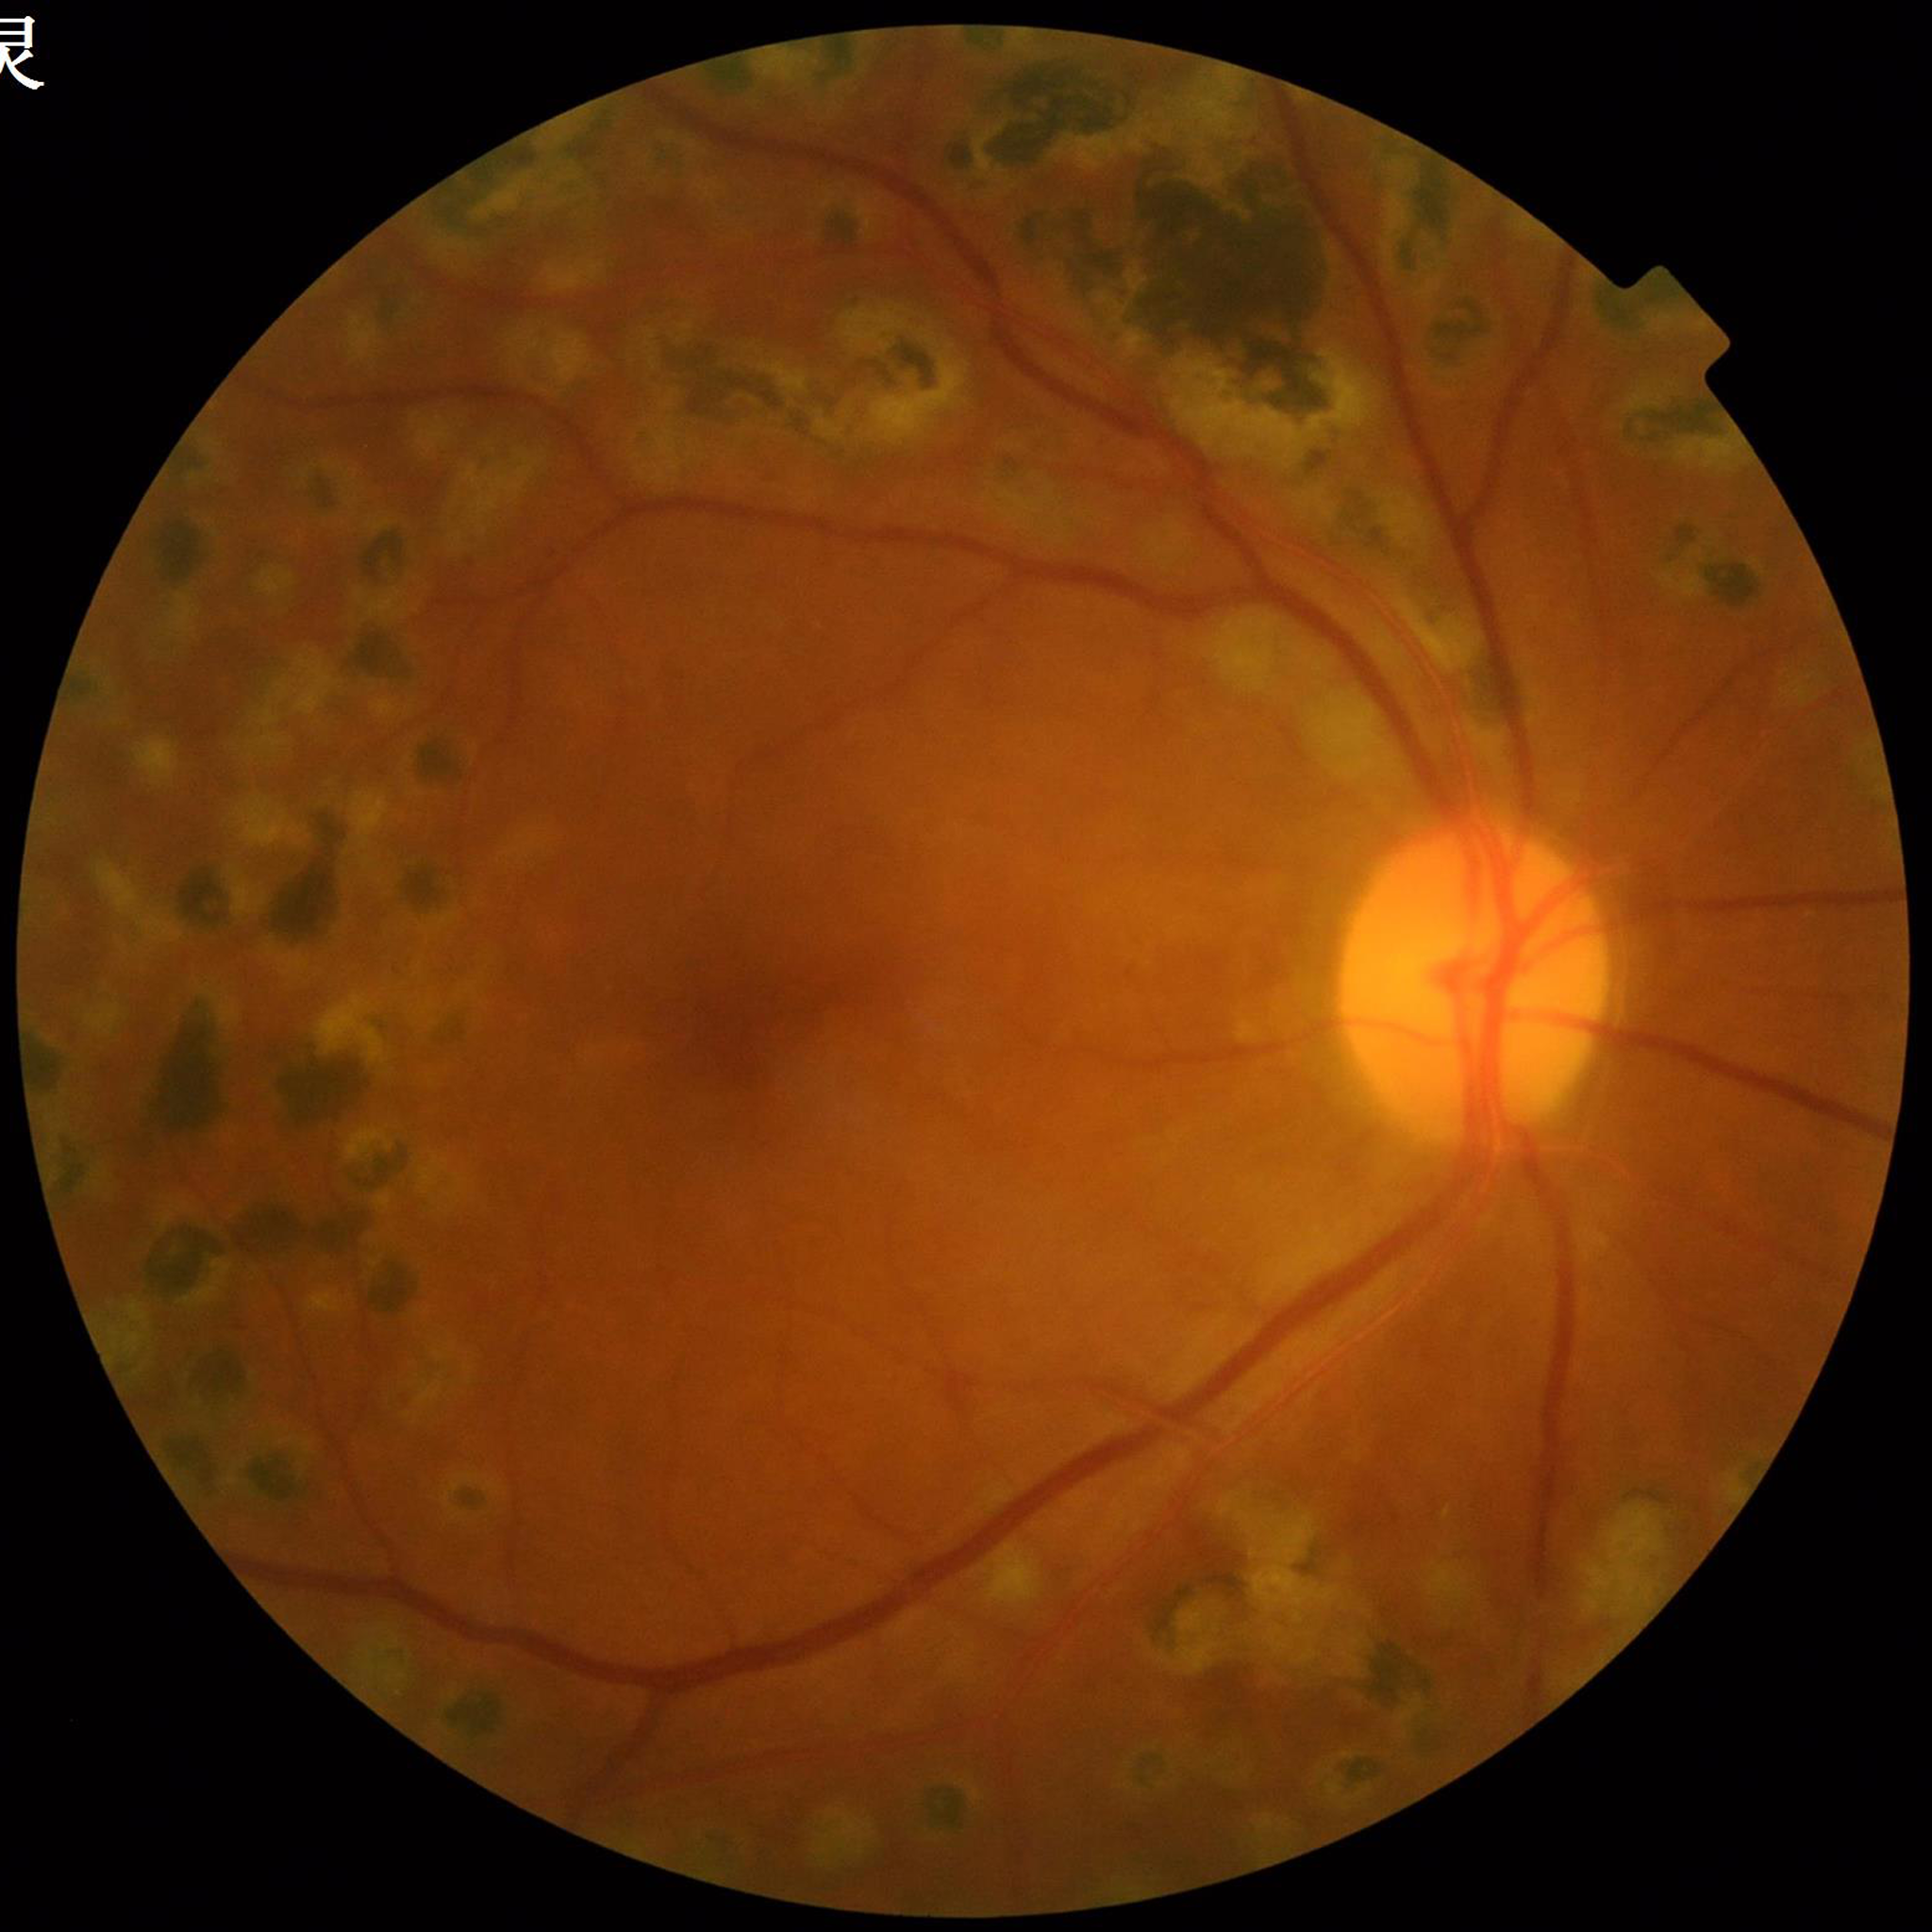

Photo quality: adequate | Clinical diagnosis: DR.